DR severity per modified Davis staging · 848x848 · 45° field of view — 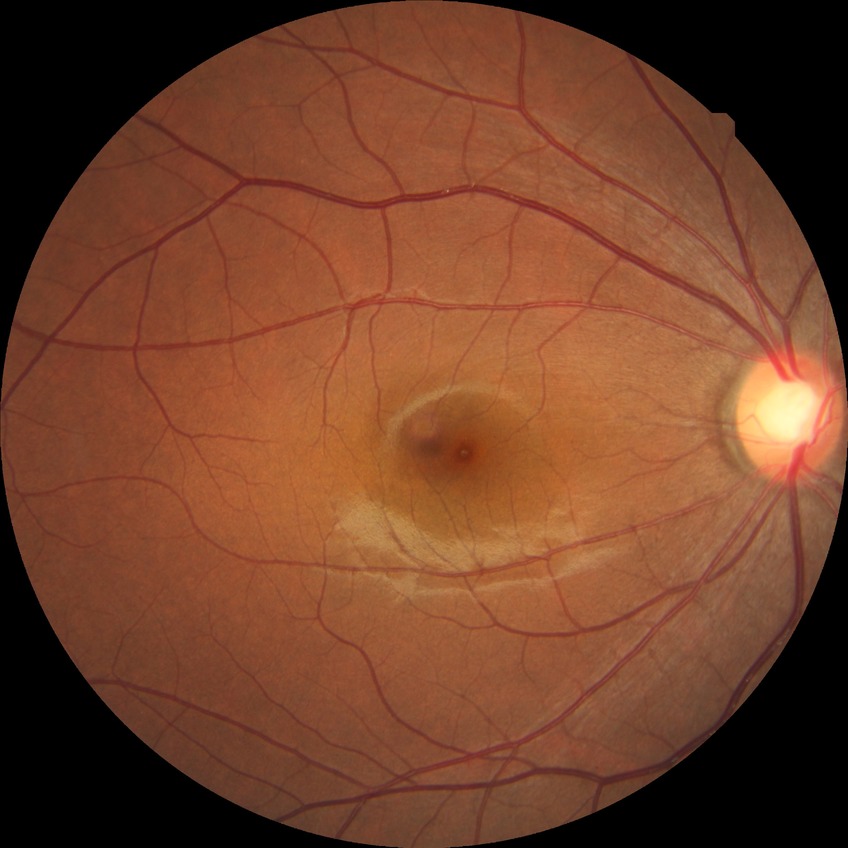
diabetic retinopathy severity: no diabetic retinopathy.